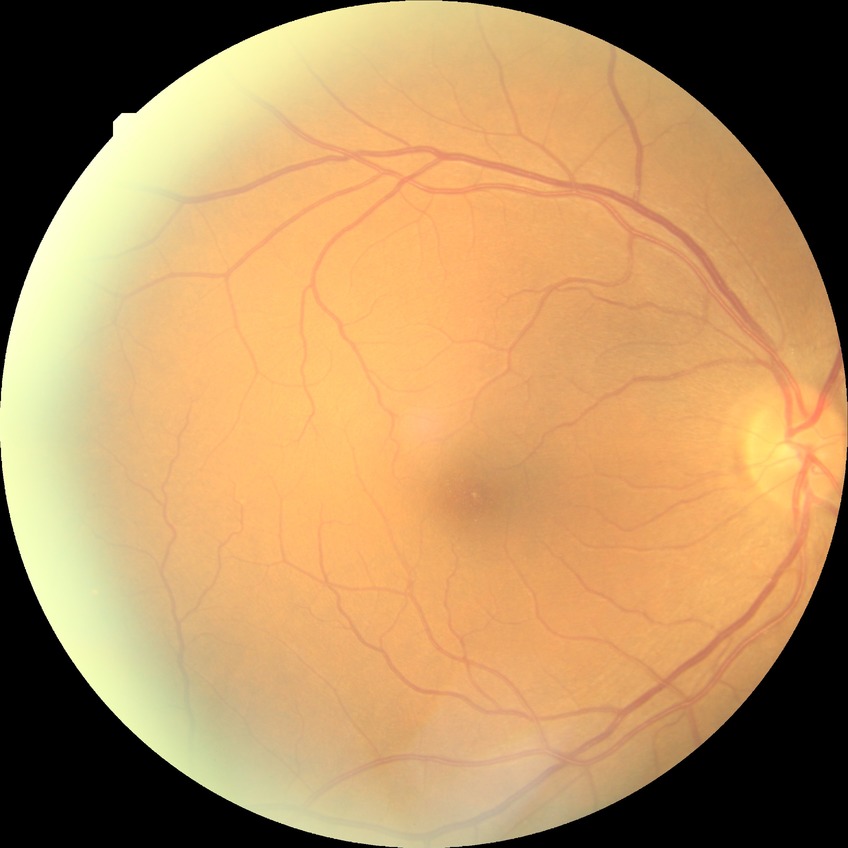 diabetic retinopathy (DR) = NDR (no diabetic retinopathy).